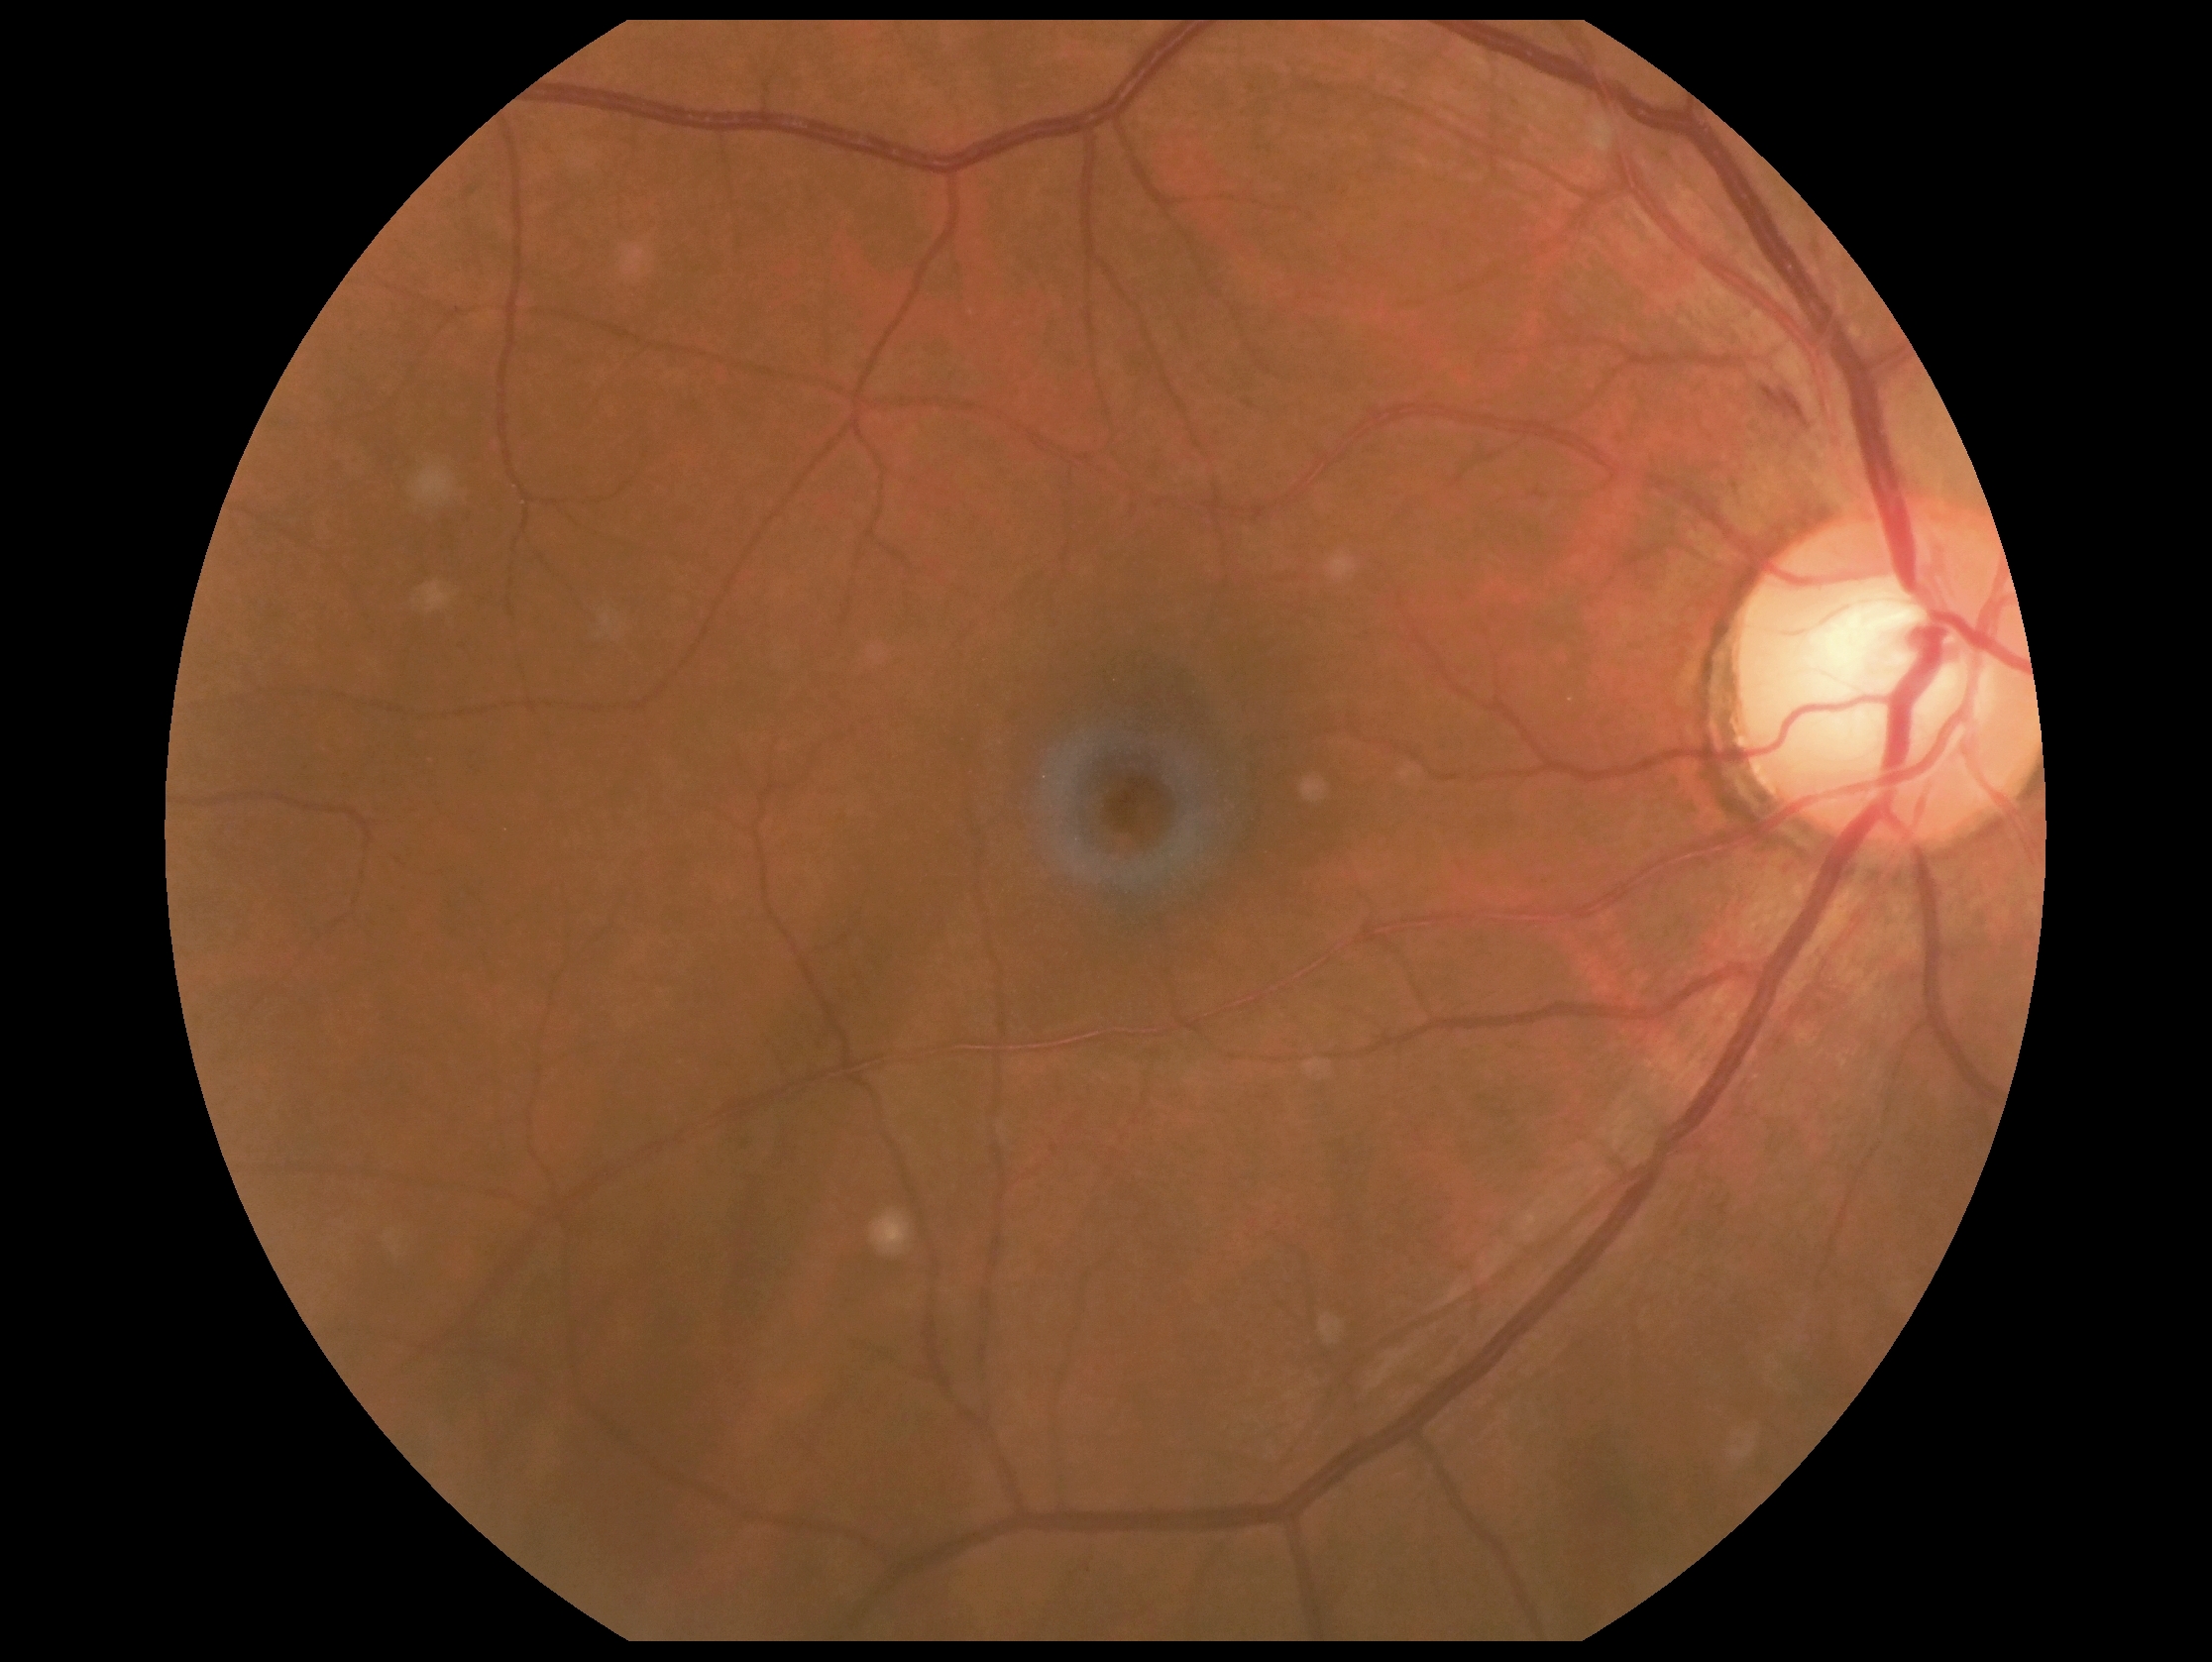

Findings:
• DR: moderate non-proliferative diabetic retinopathy (grade 2)
• DR class: non-proliferative diabetic retinopathy